640 x 480 pixels; RetCam wide-field infant fundus image: 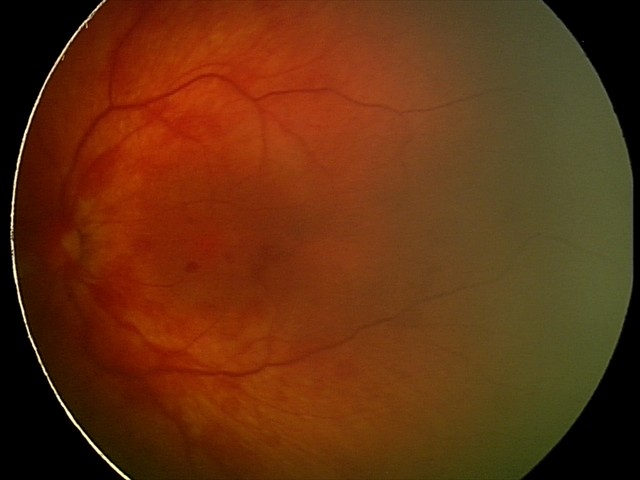

From an examination with diagnosis of retinal hemorrhages.